2352 x 1568 pixels:
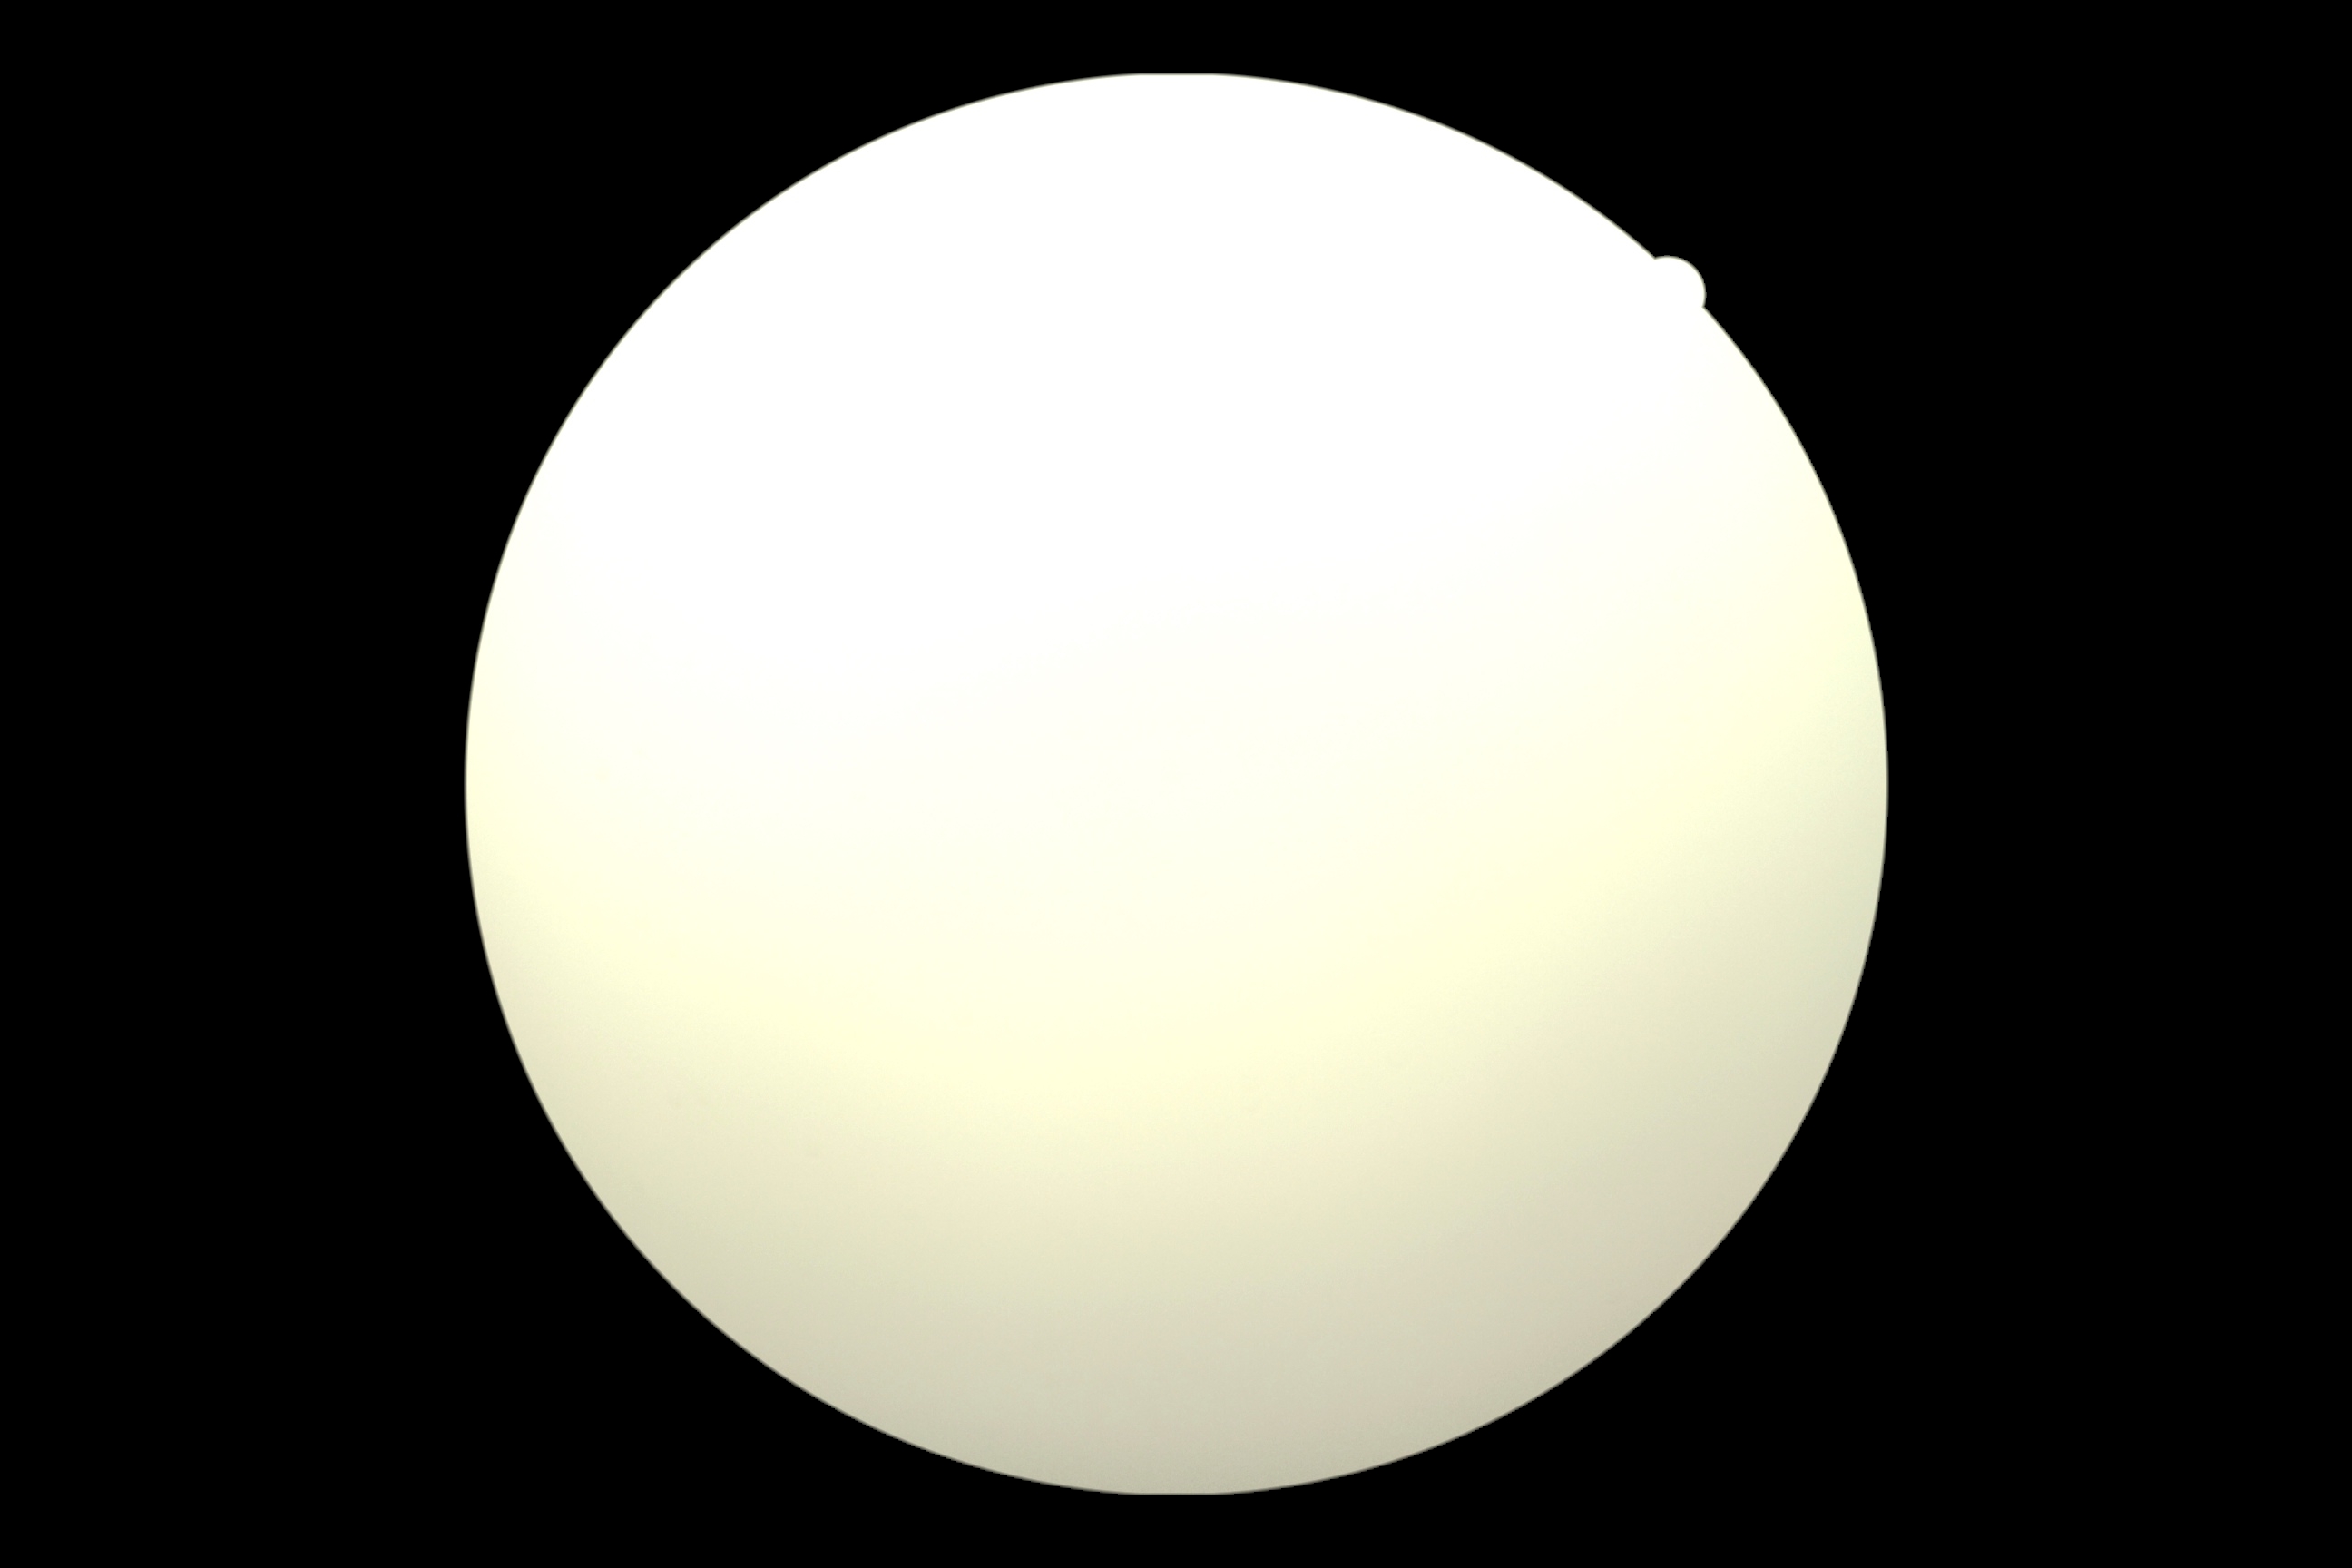 Retinopathy grade: ungradable due to poor image quality.